1240x1240px; pediatric retinal photograph (wide-field)
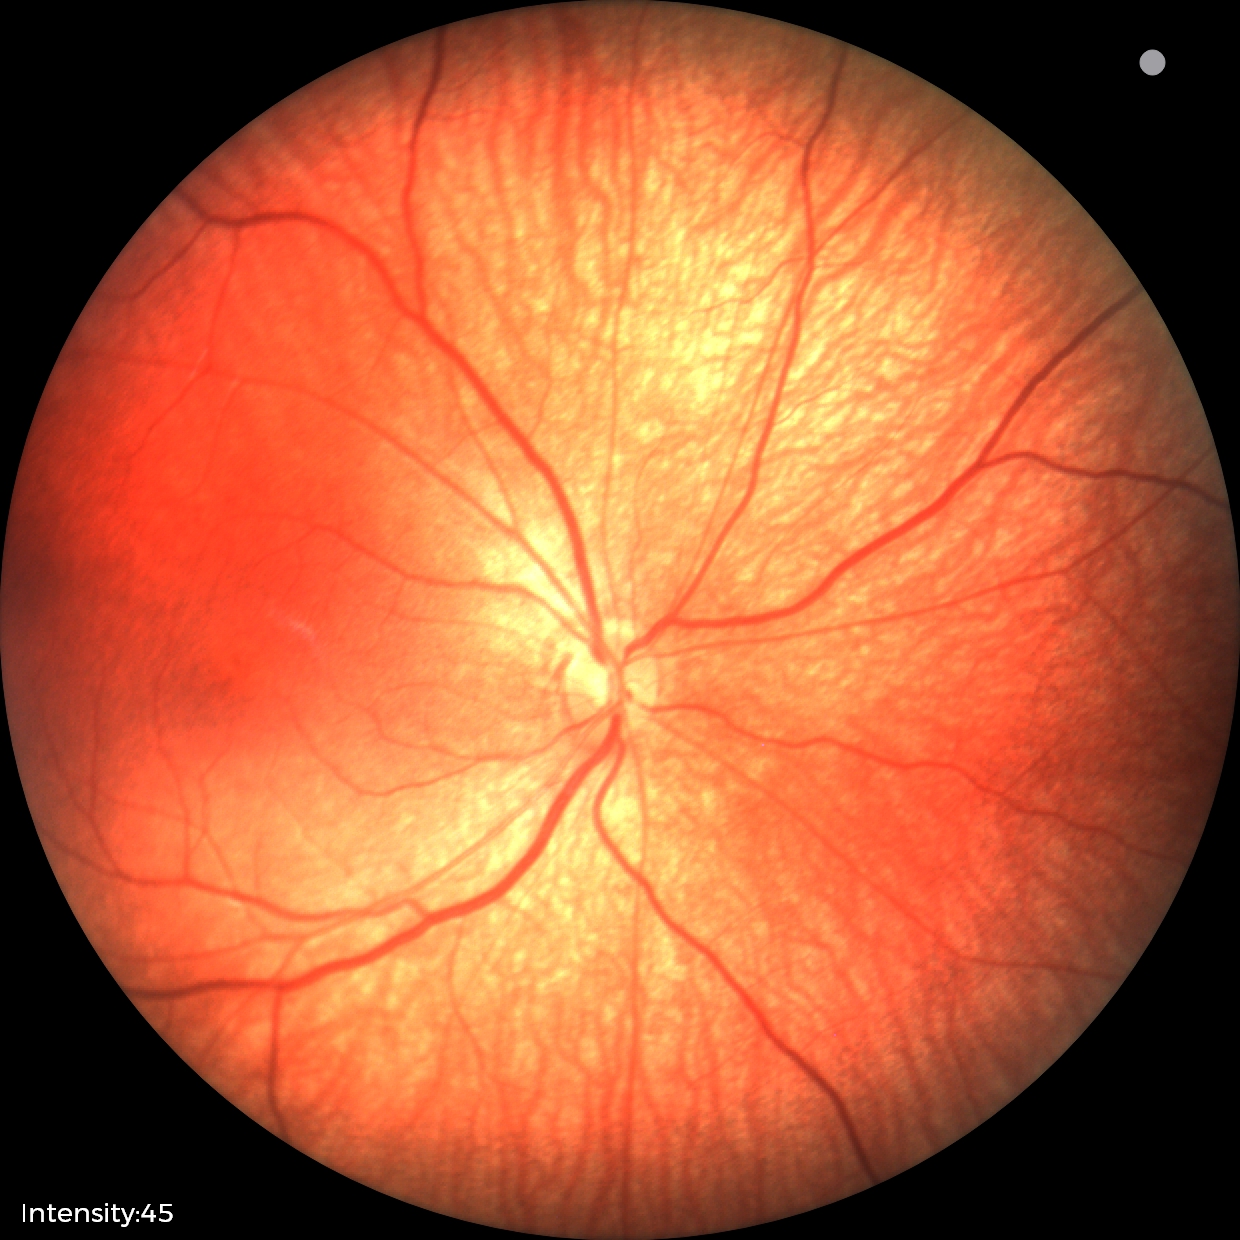 Screening examination with no abnormal retinal findings.